FOV: 45 degrees; DR severity per modified Davis staging:
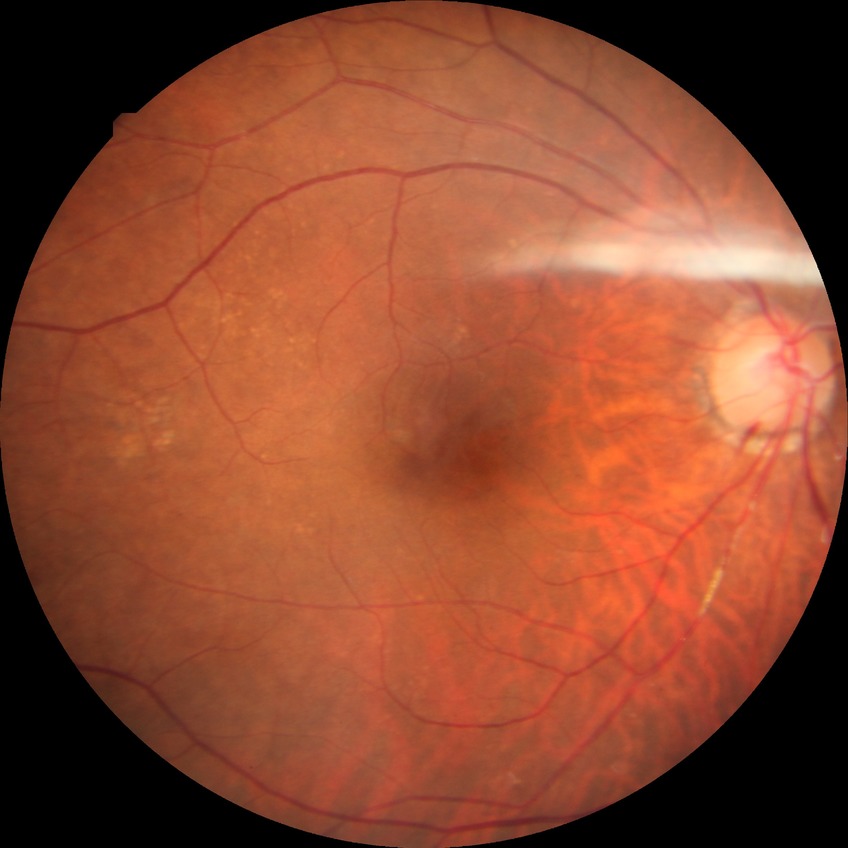
Modified Davis grading: no diabetic retinopathy.